1240 by 1240 pixels · pediatric retinal photograph (wide-field)
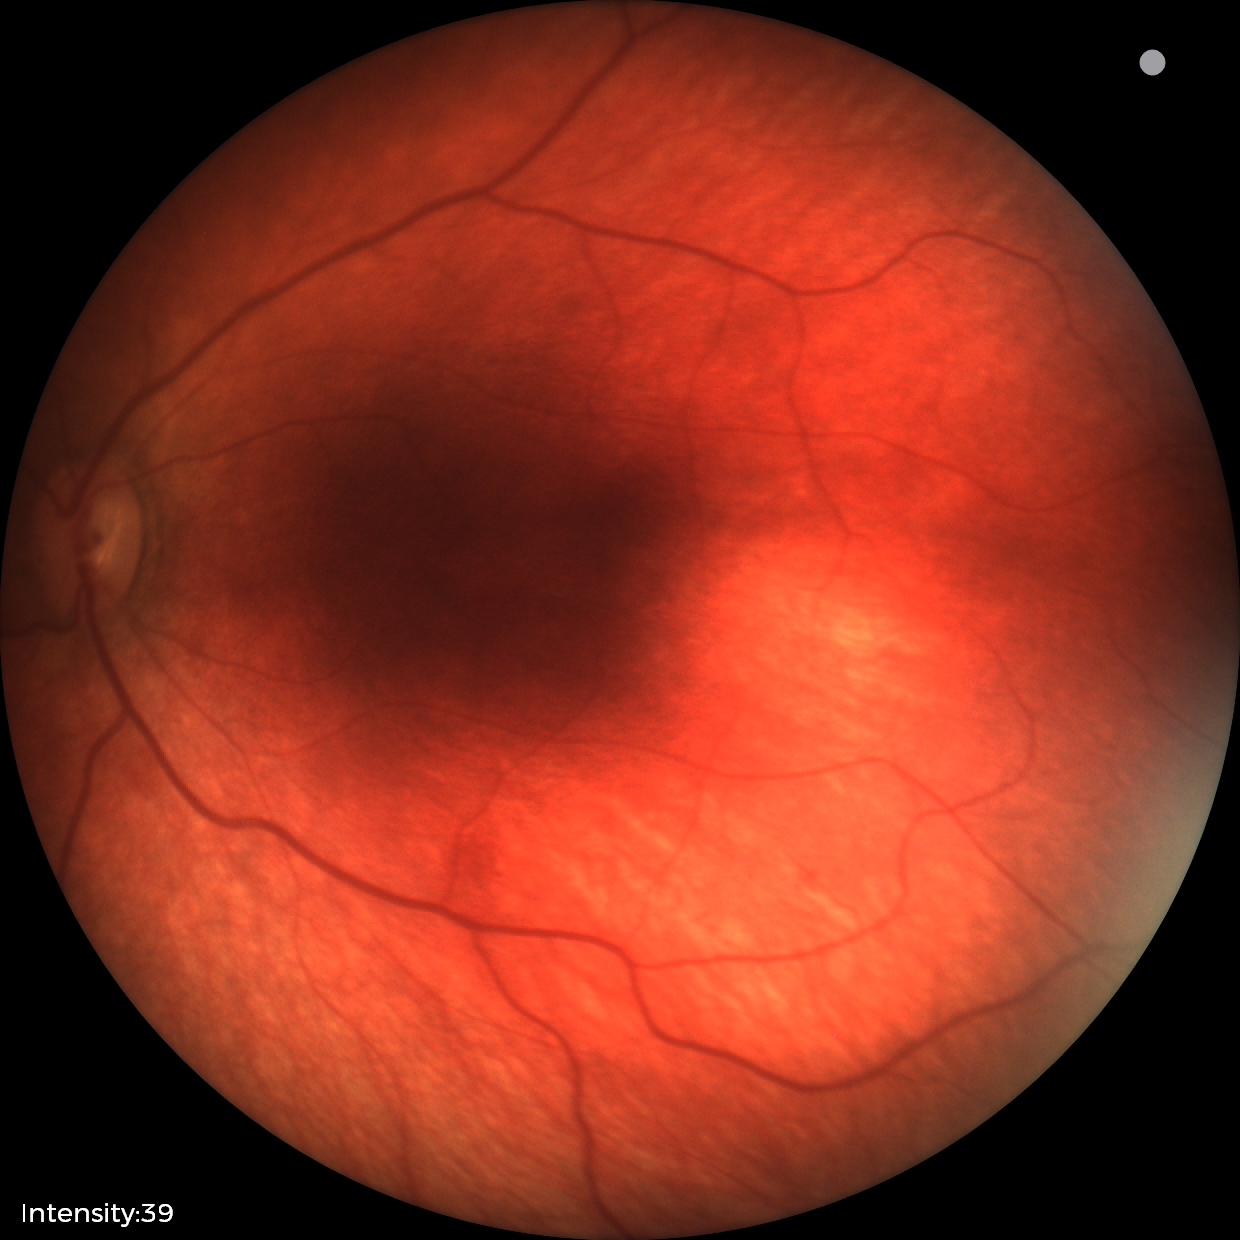 Q: What is the diagnosis from this examination?
A: retinal hemorrhages